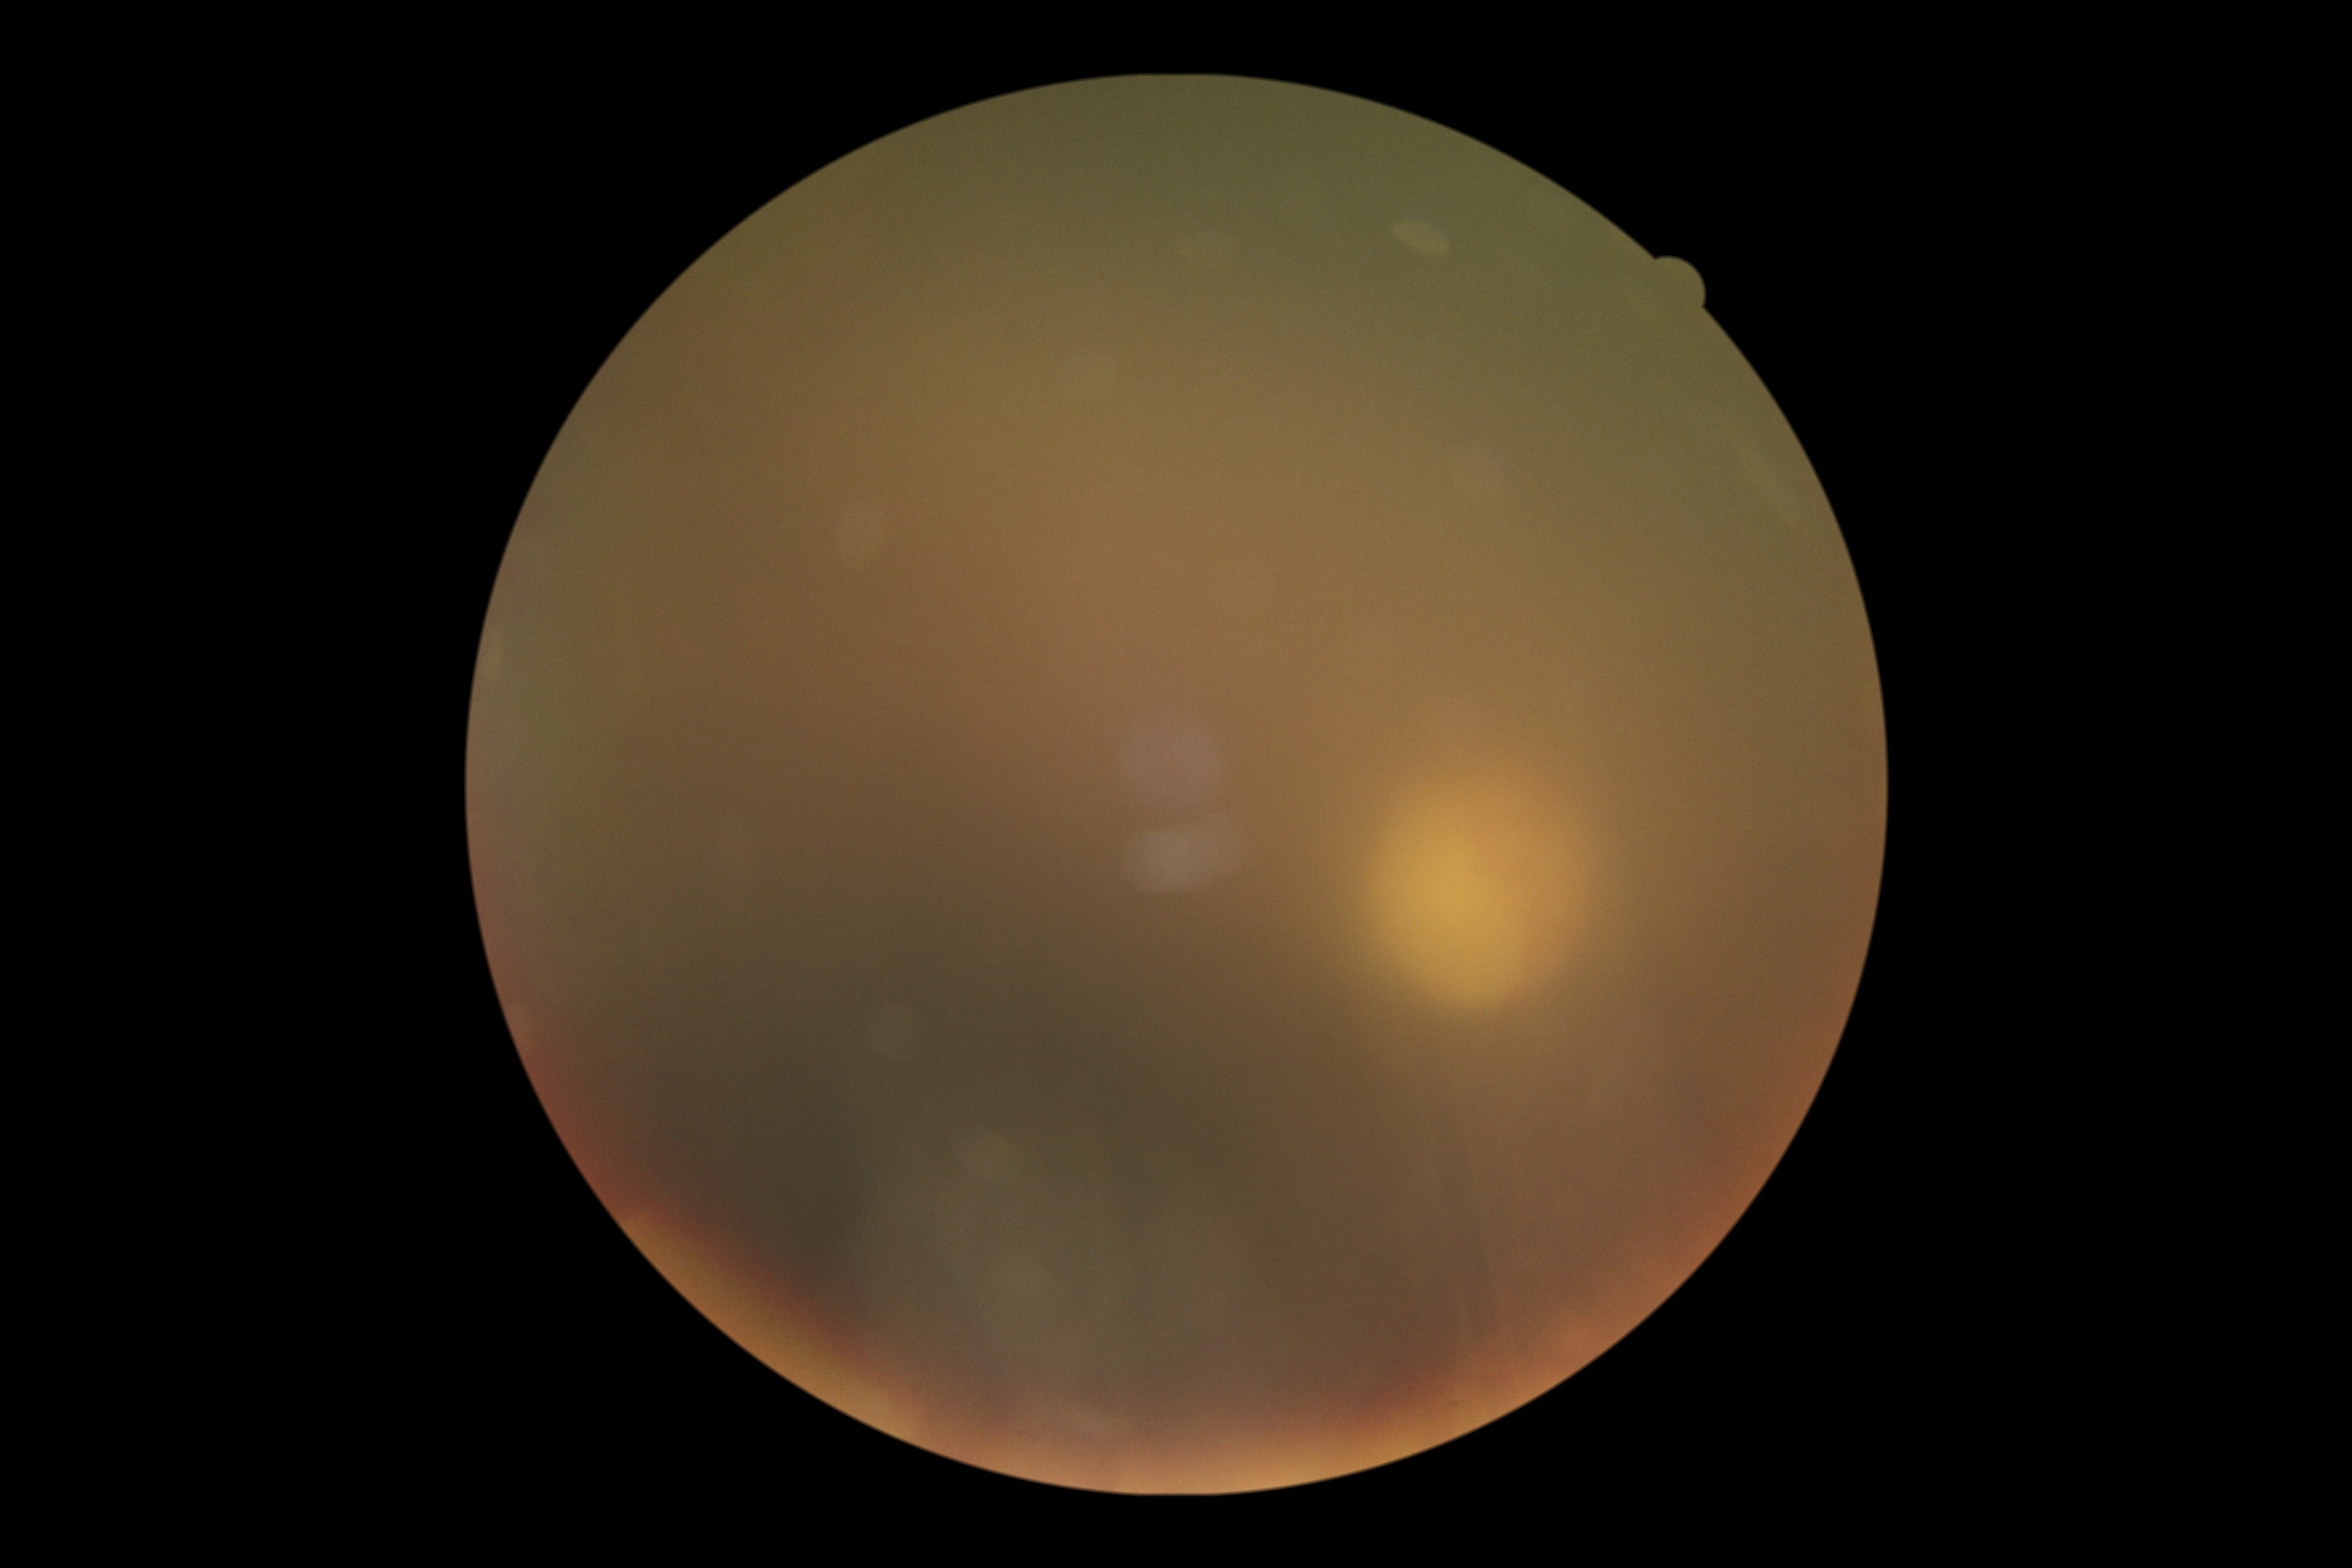
Diabetic retinopathy (DR): ungradable due to poor image quality.